2089 x 1764 pixels.
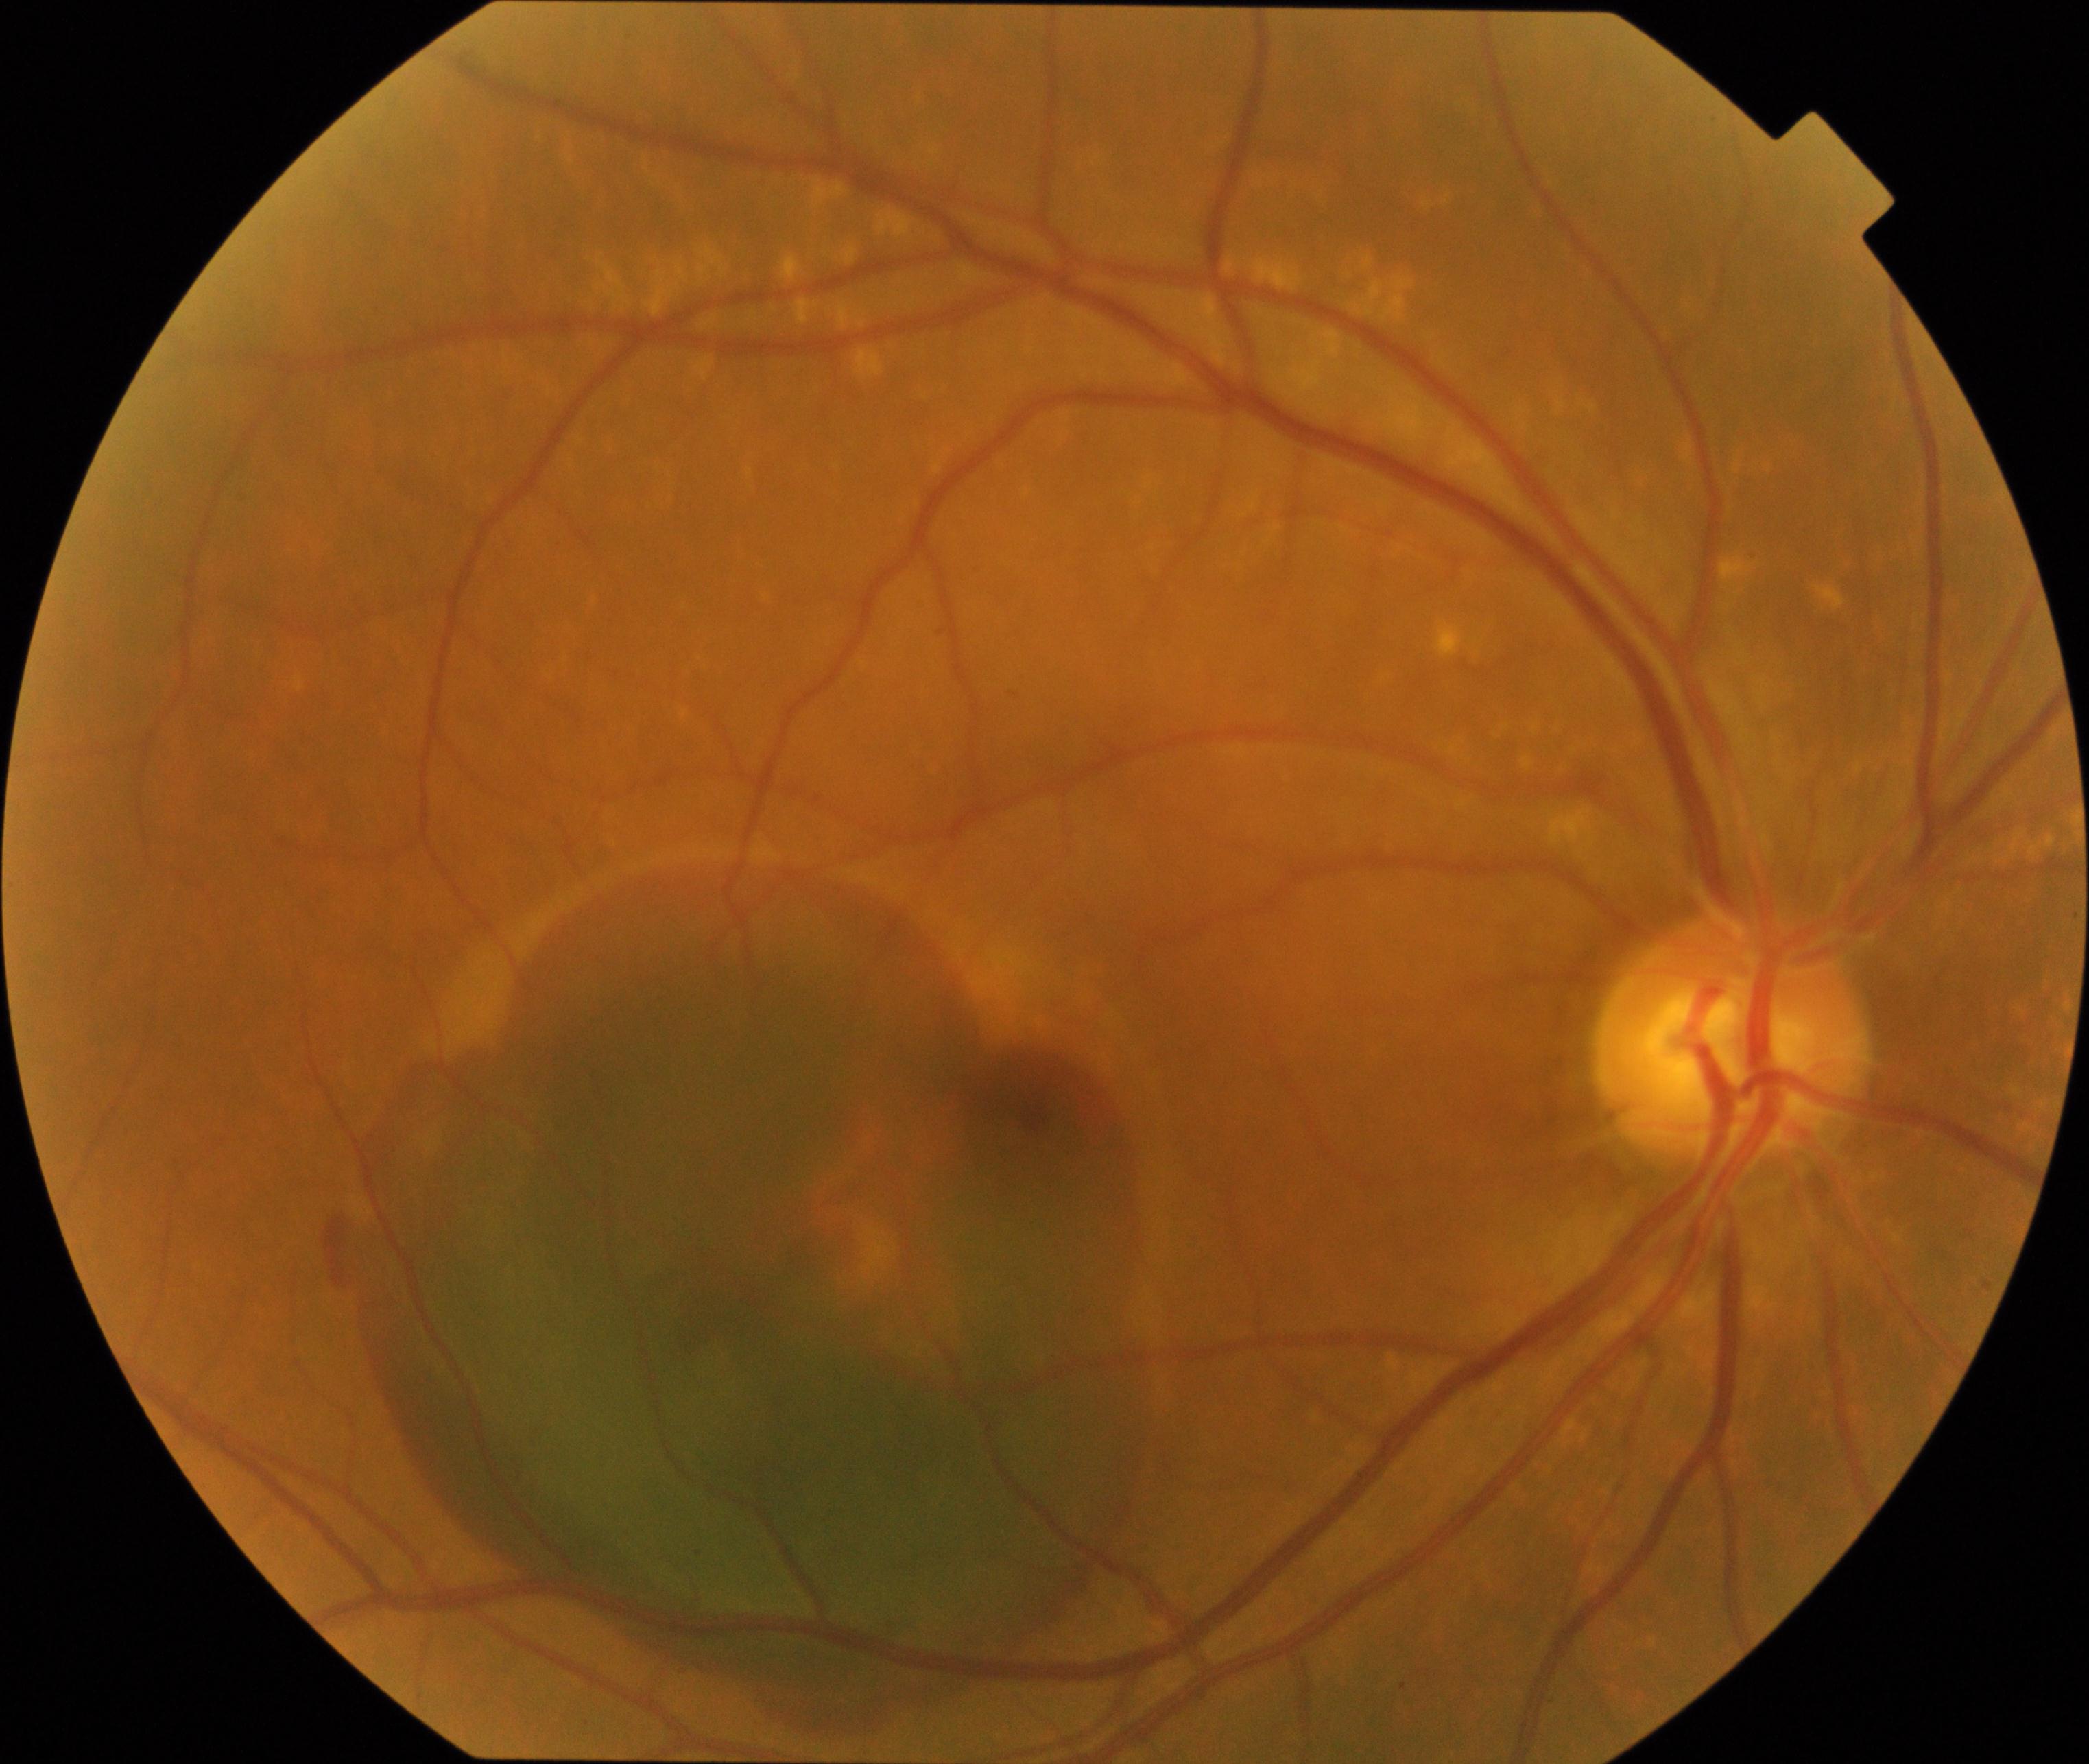 Impression: maculopathy.